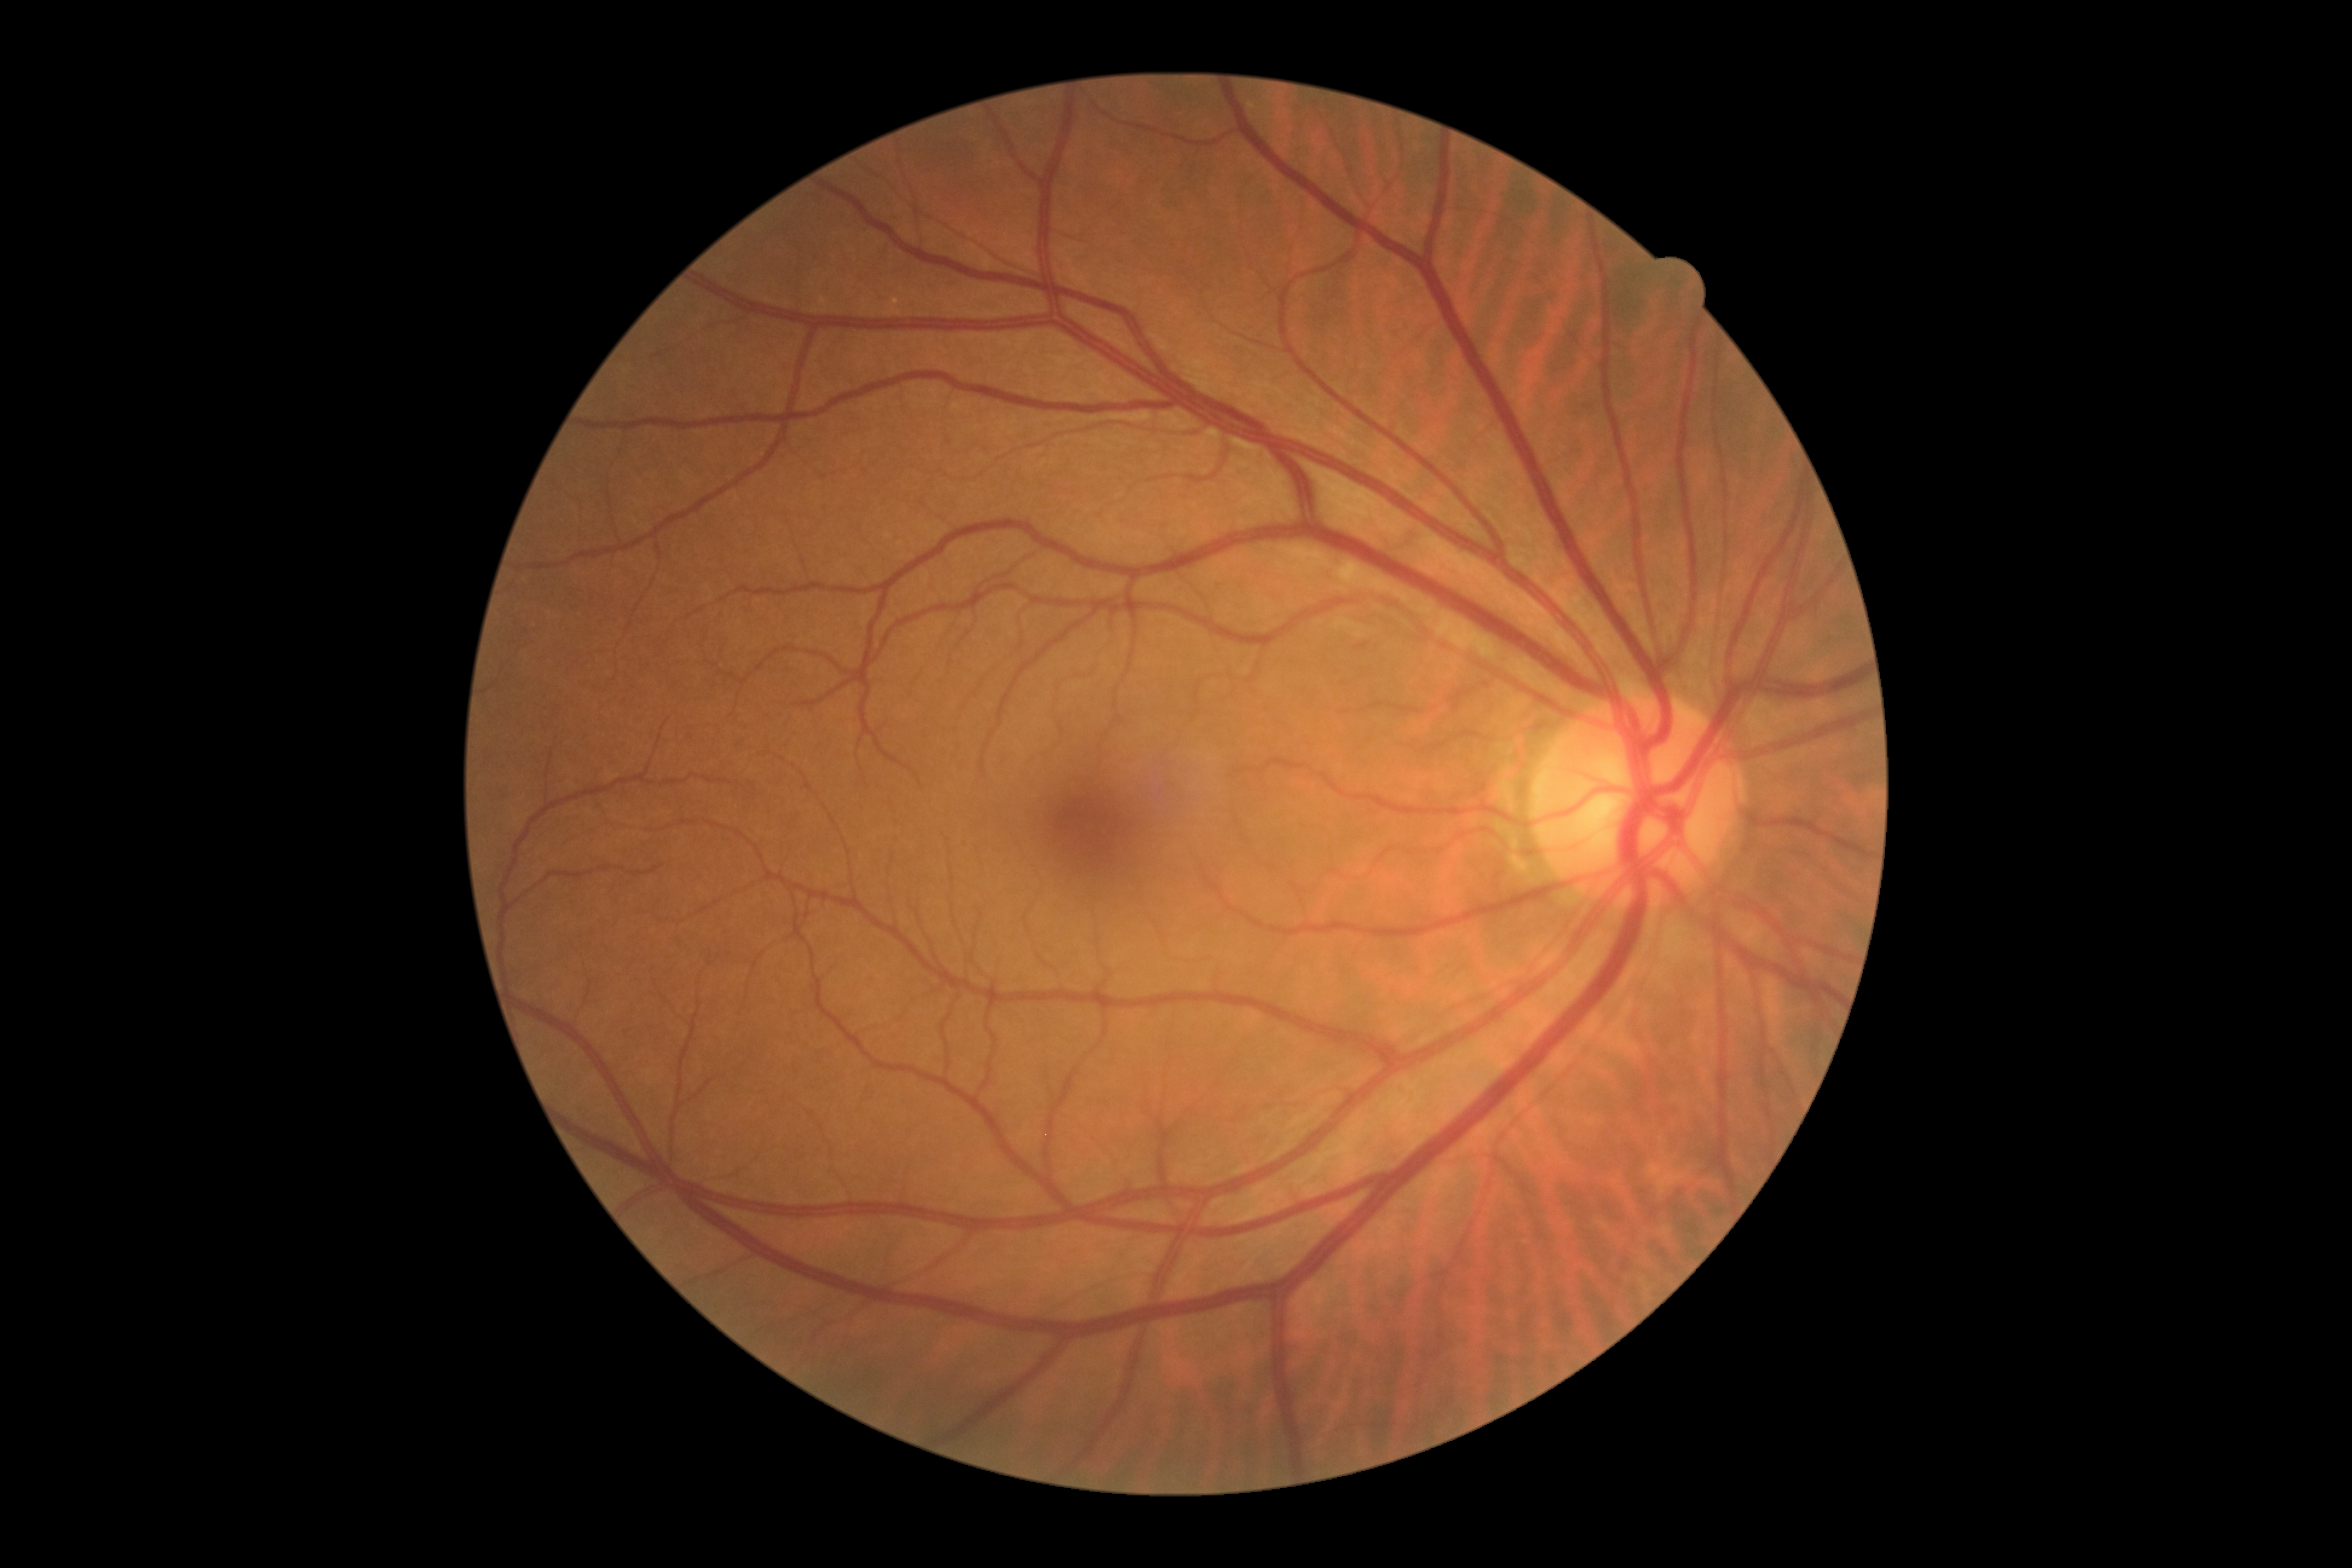 No diabetic retinal disease findings. DR stage: grade 0 (no apparent retinopathy).